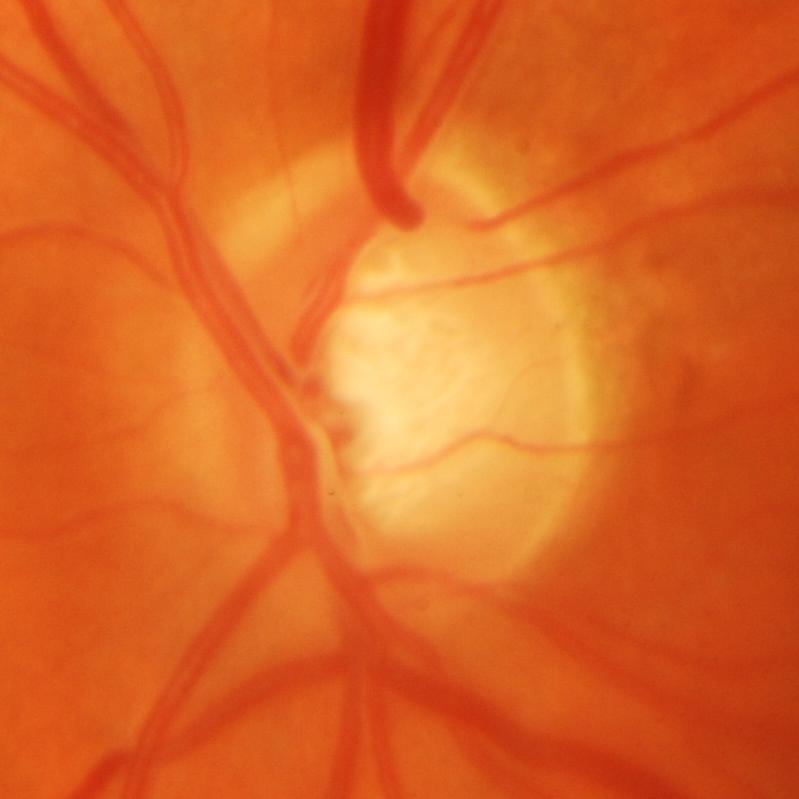

Glaucoma status: present.